Fundus photo — 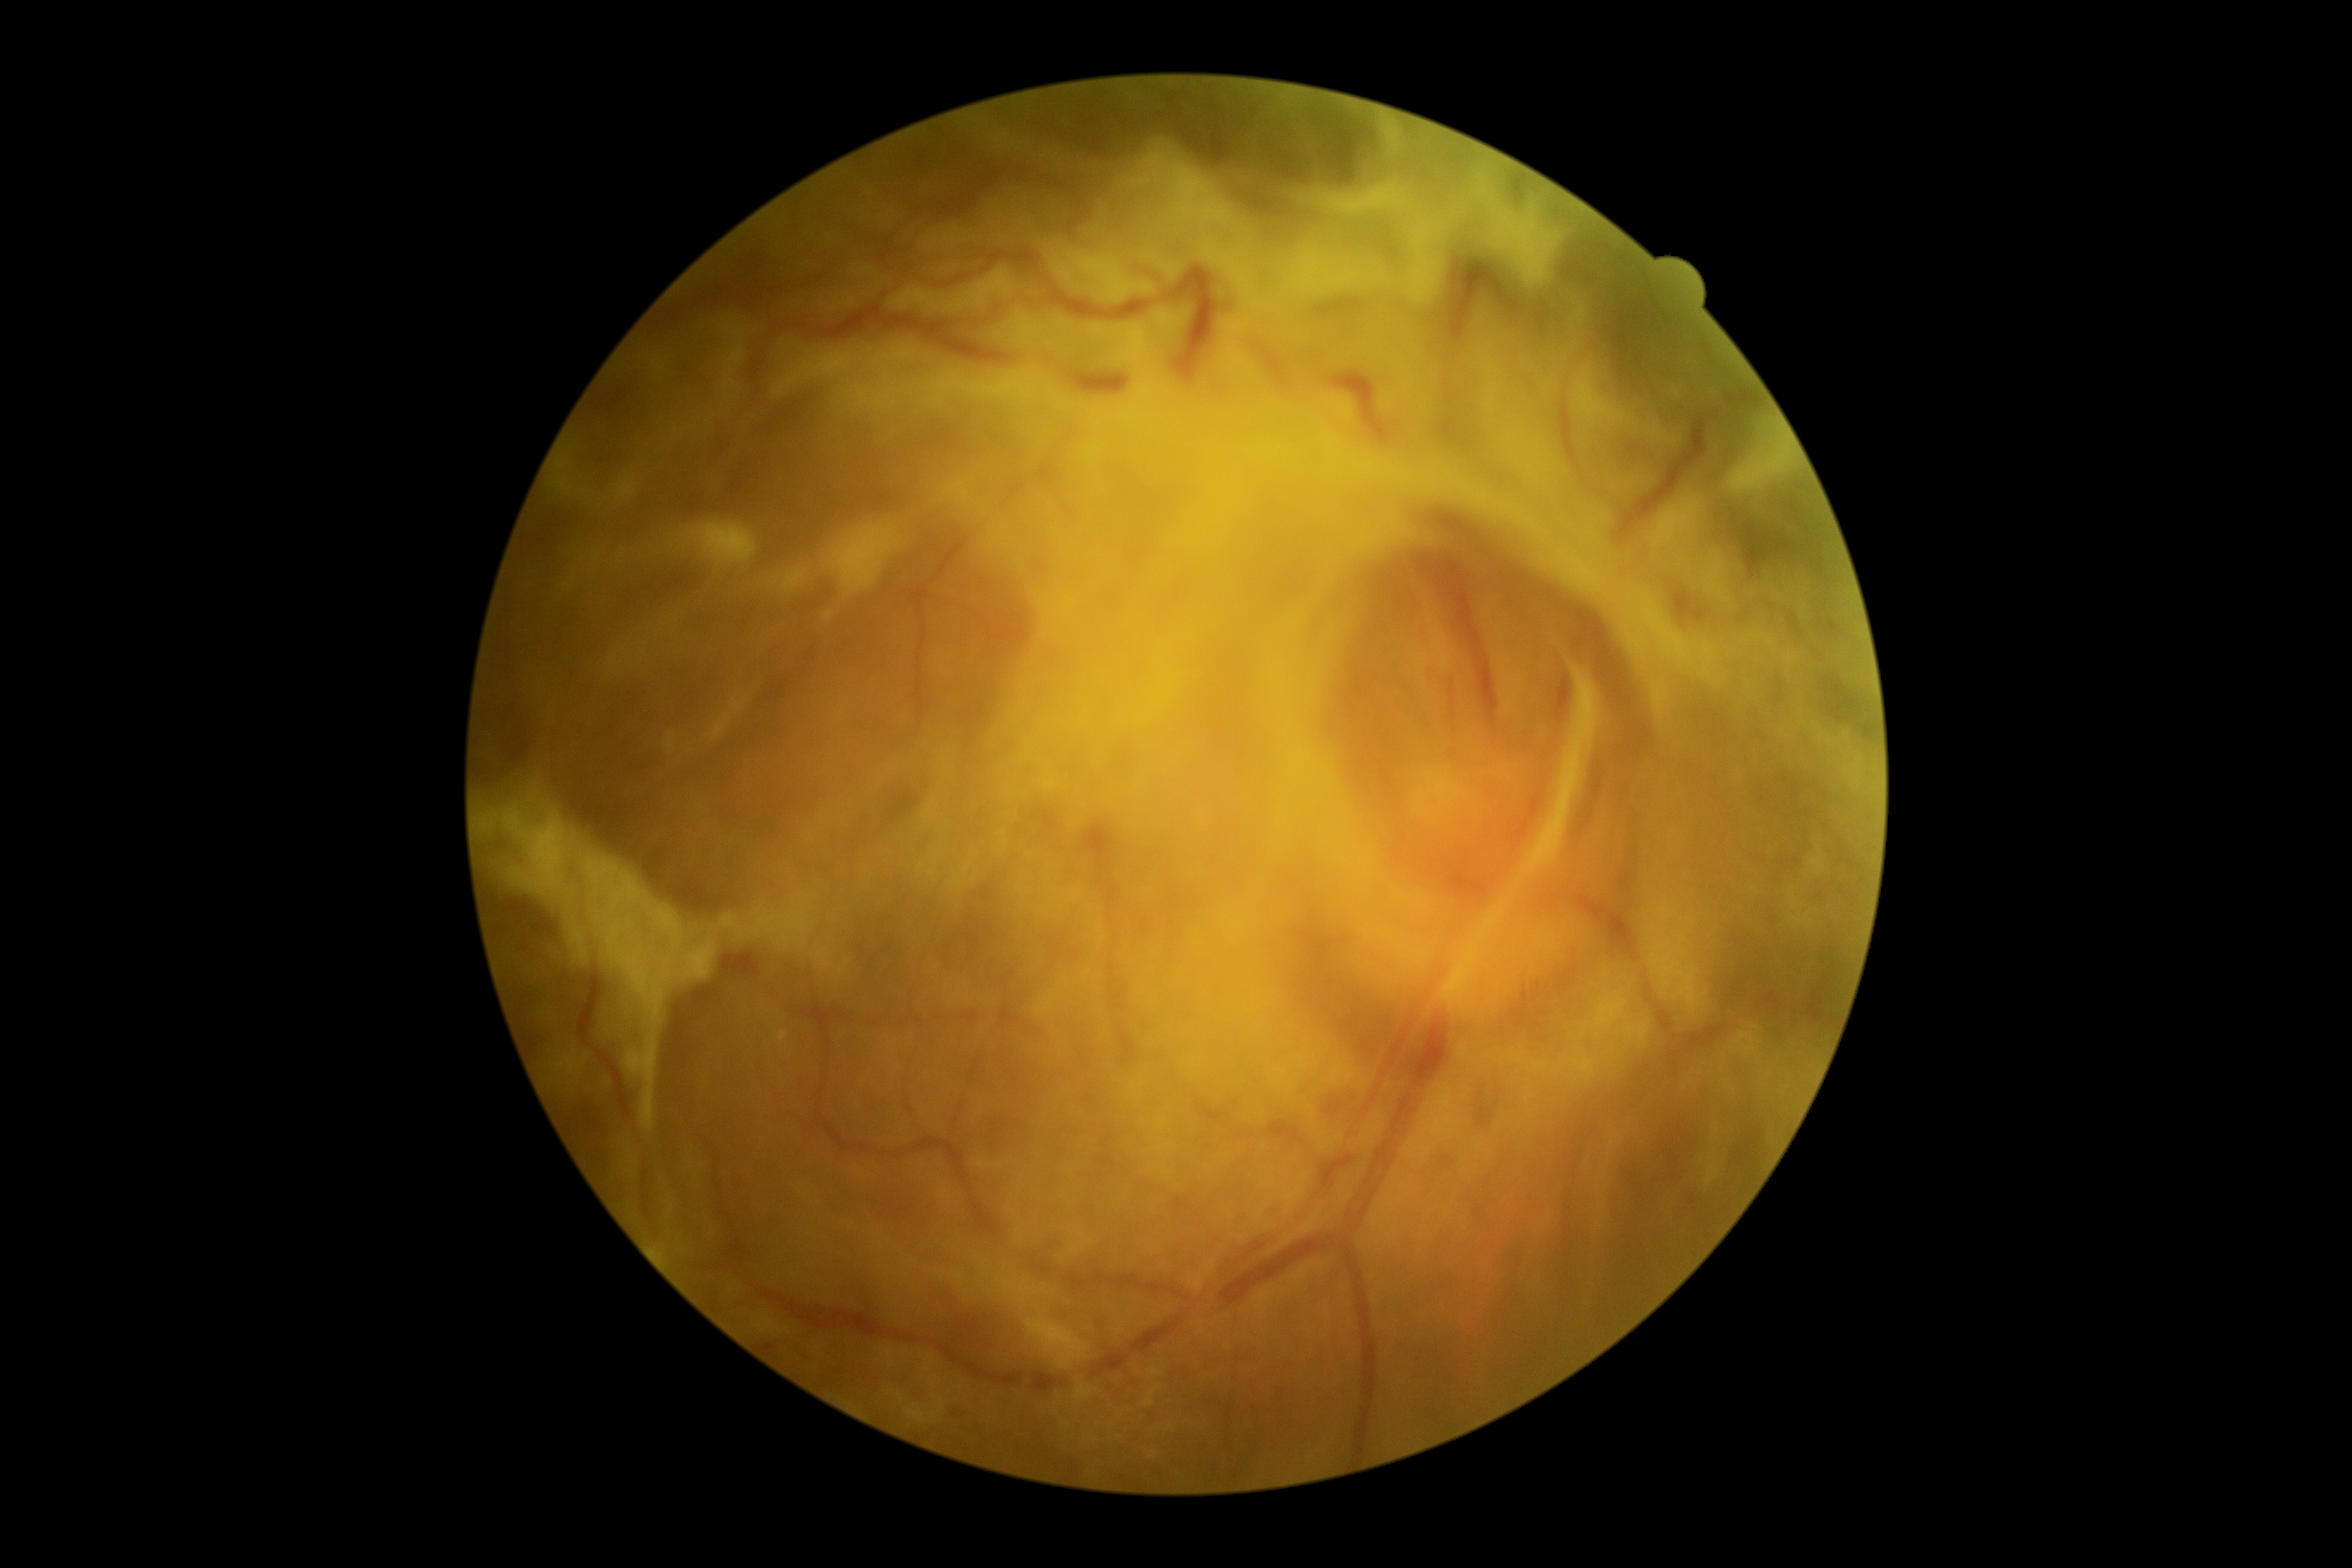

The retinopathy is classified as proliferative diabetic retinopathy. DR: grade 4 (PDR) — neovascularization and/or vitreous/pre-retinal hemorrhage.